Infant wide-field retinal image: 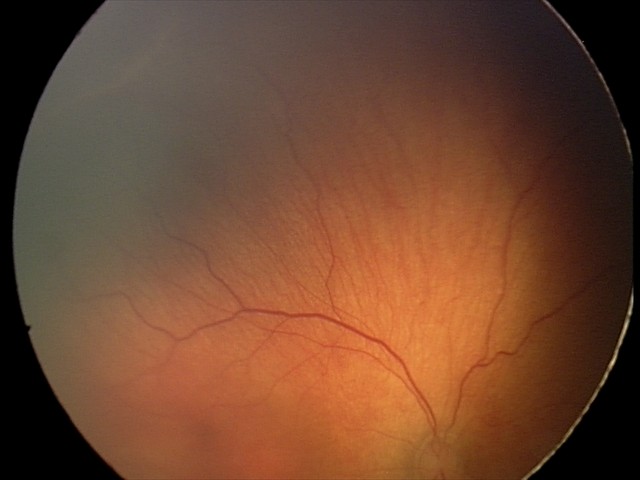 Plus disease: absent, impression: ROP stage 2 — ridge with height and width at the demarcation line.